Image size 2048x1536; color fundus photograph.
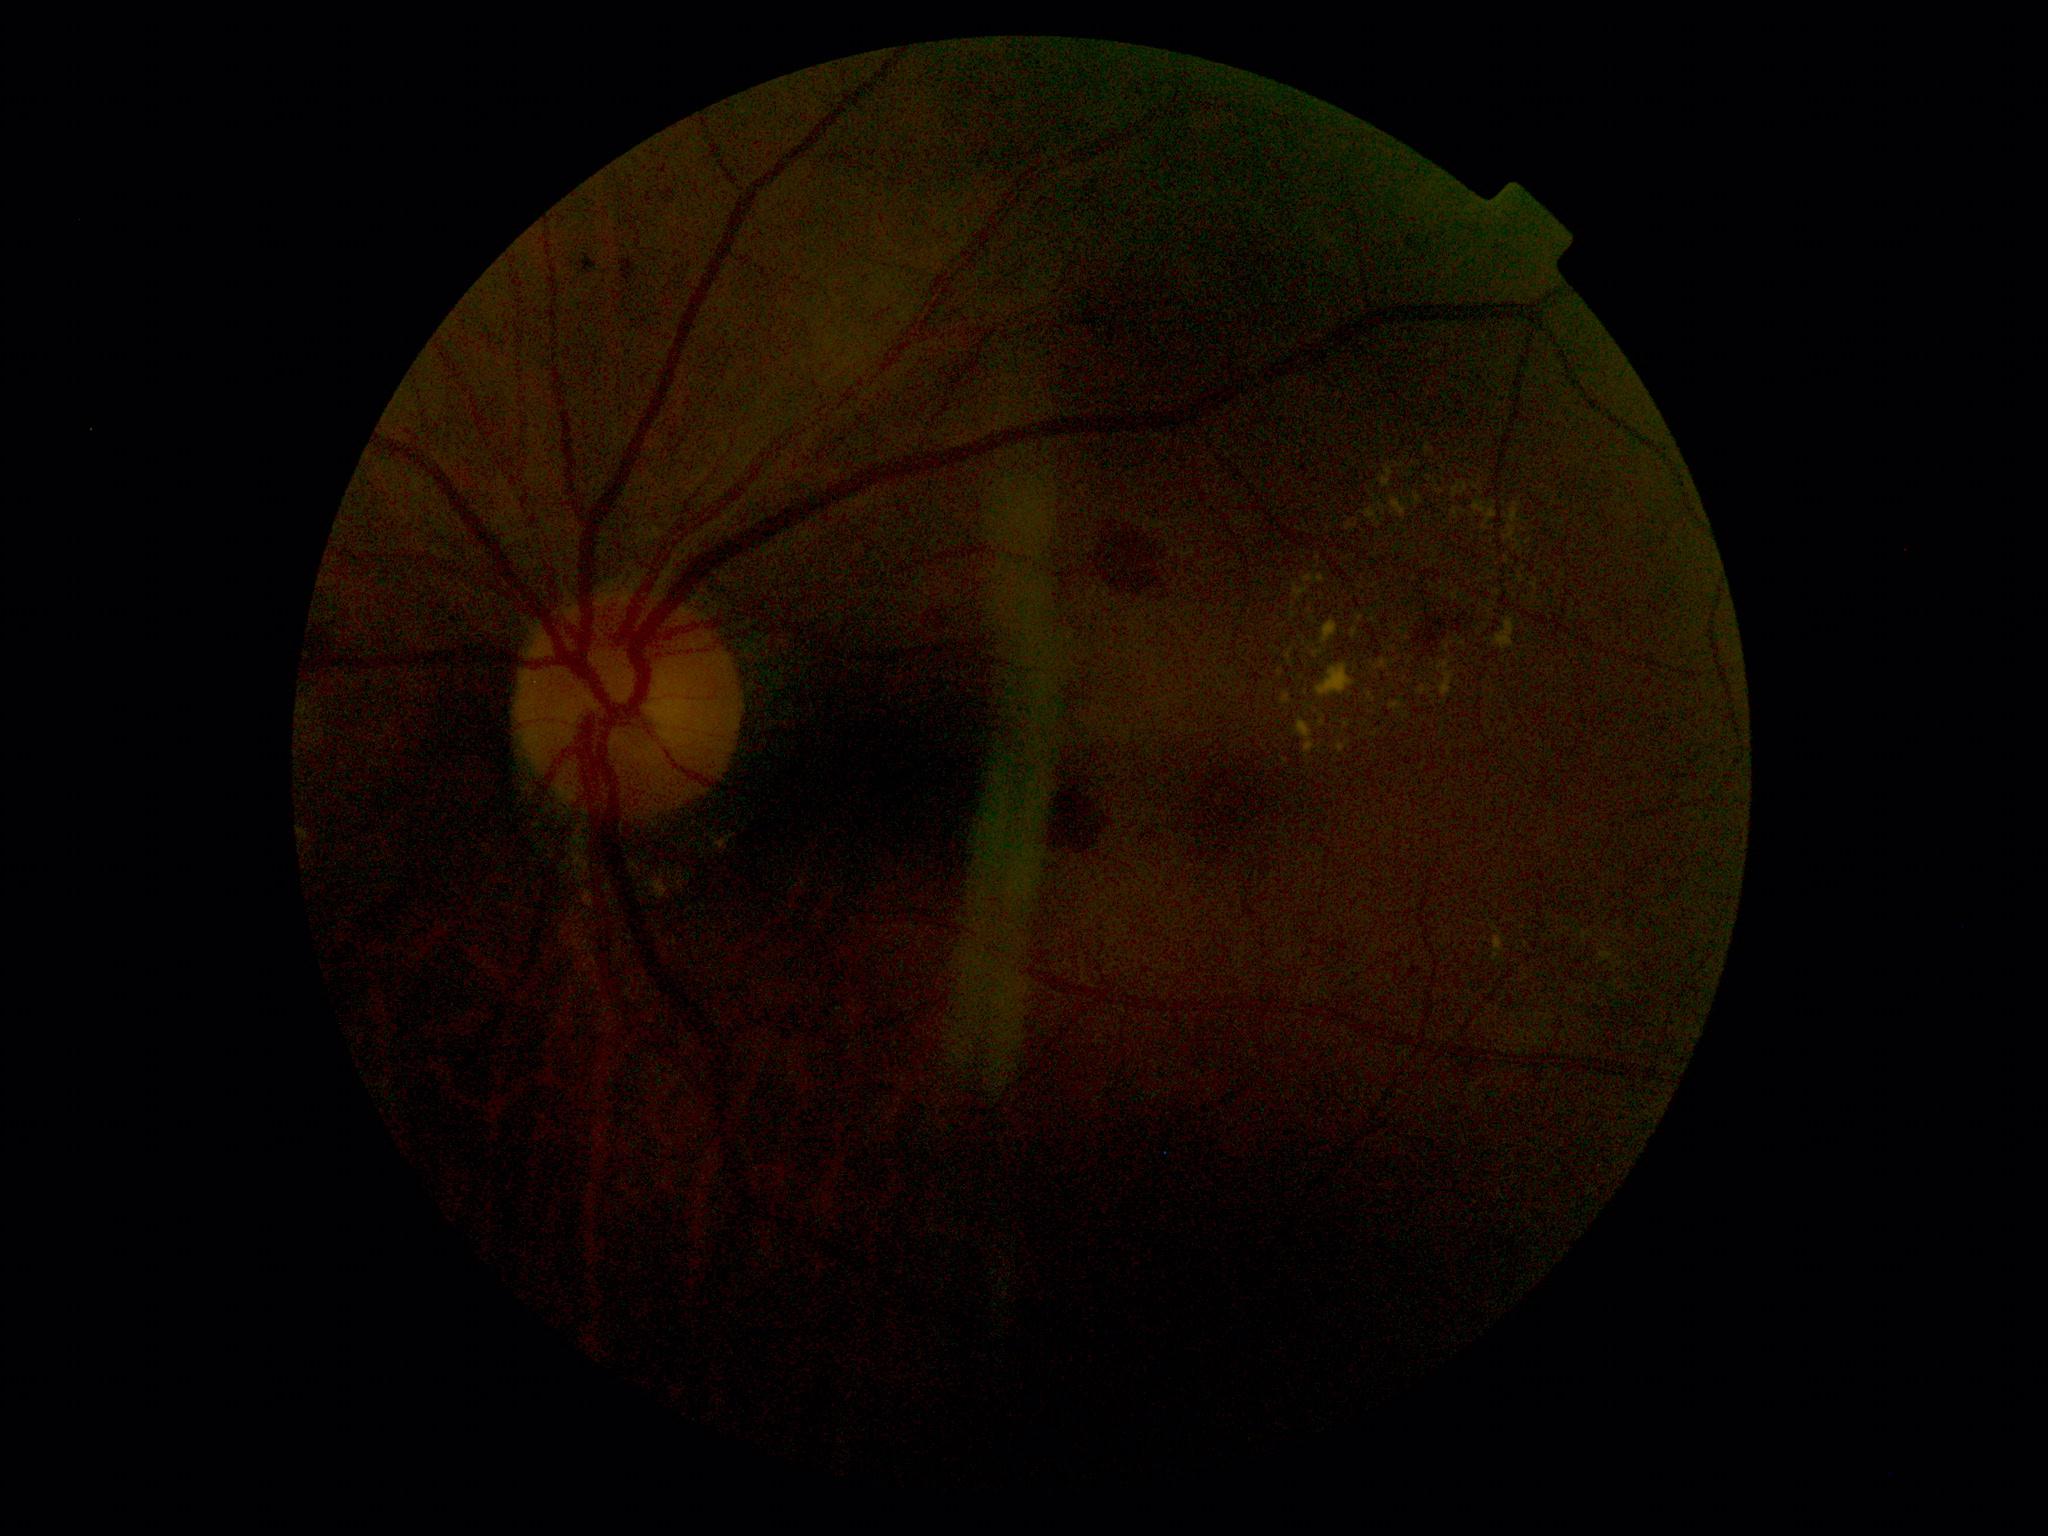
The retinopathy is classified as non-proliferative diabetic retinopathy.
Diabetic retinopathy (DR): grade 2 (moderate NPDR).